Image size 640x480. Wide-field fundus photograph from neonatal ROP screening. 130° field of view (Clarity RetCam 3) — 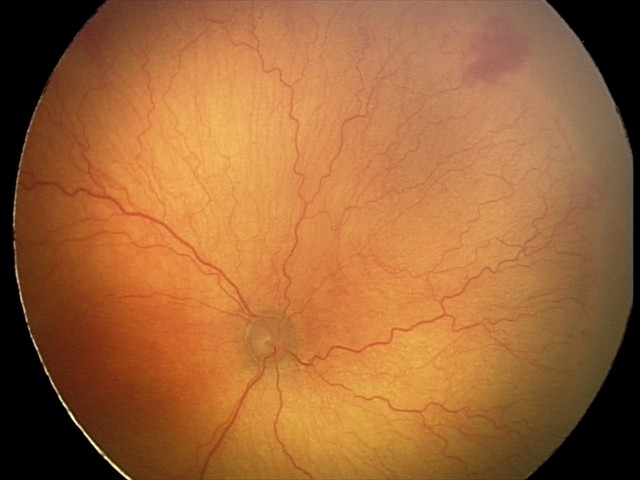

With plus disease. Examination diagnosed as A-ROP (aggressive ROP).